Color fundus image; 45-degree field of view: 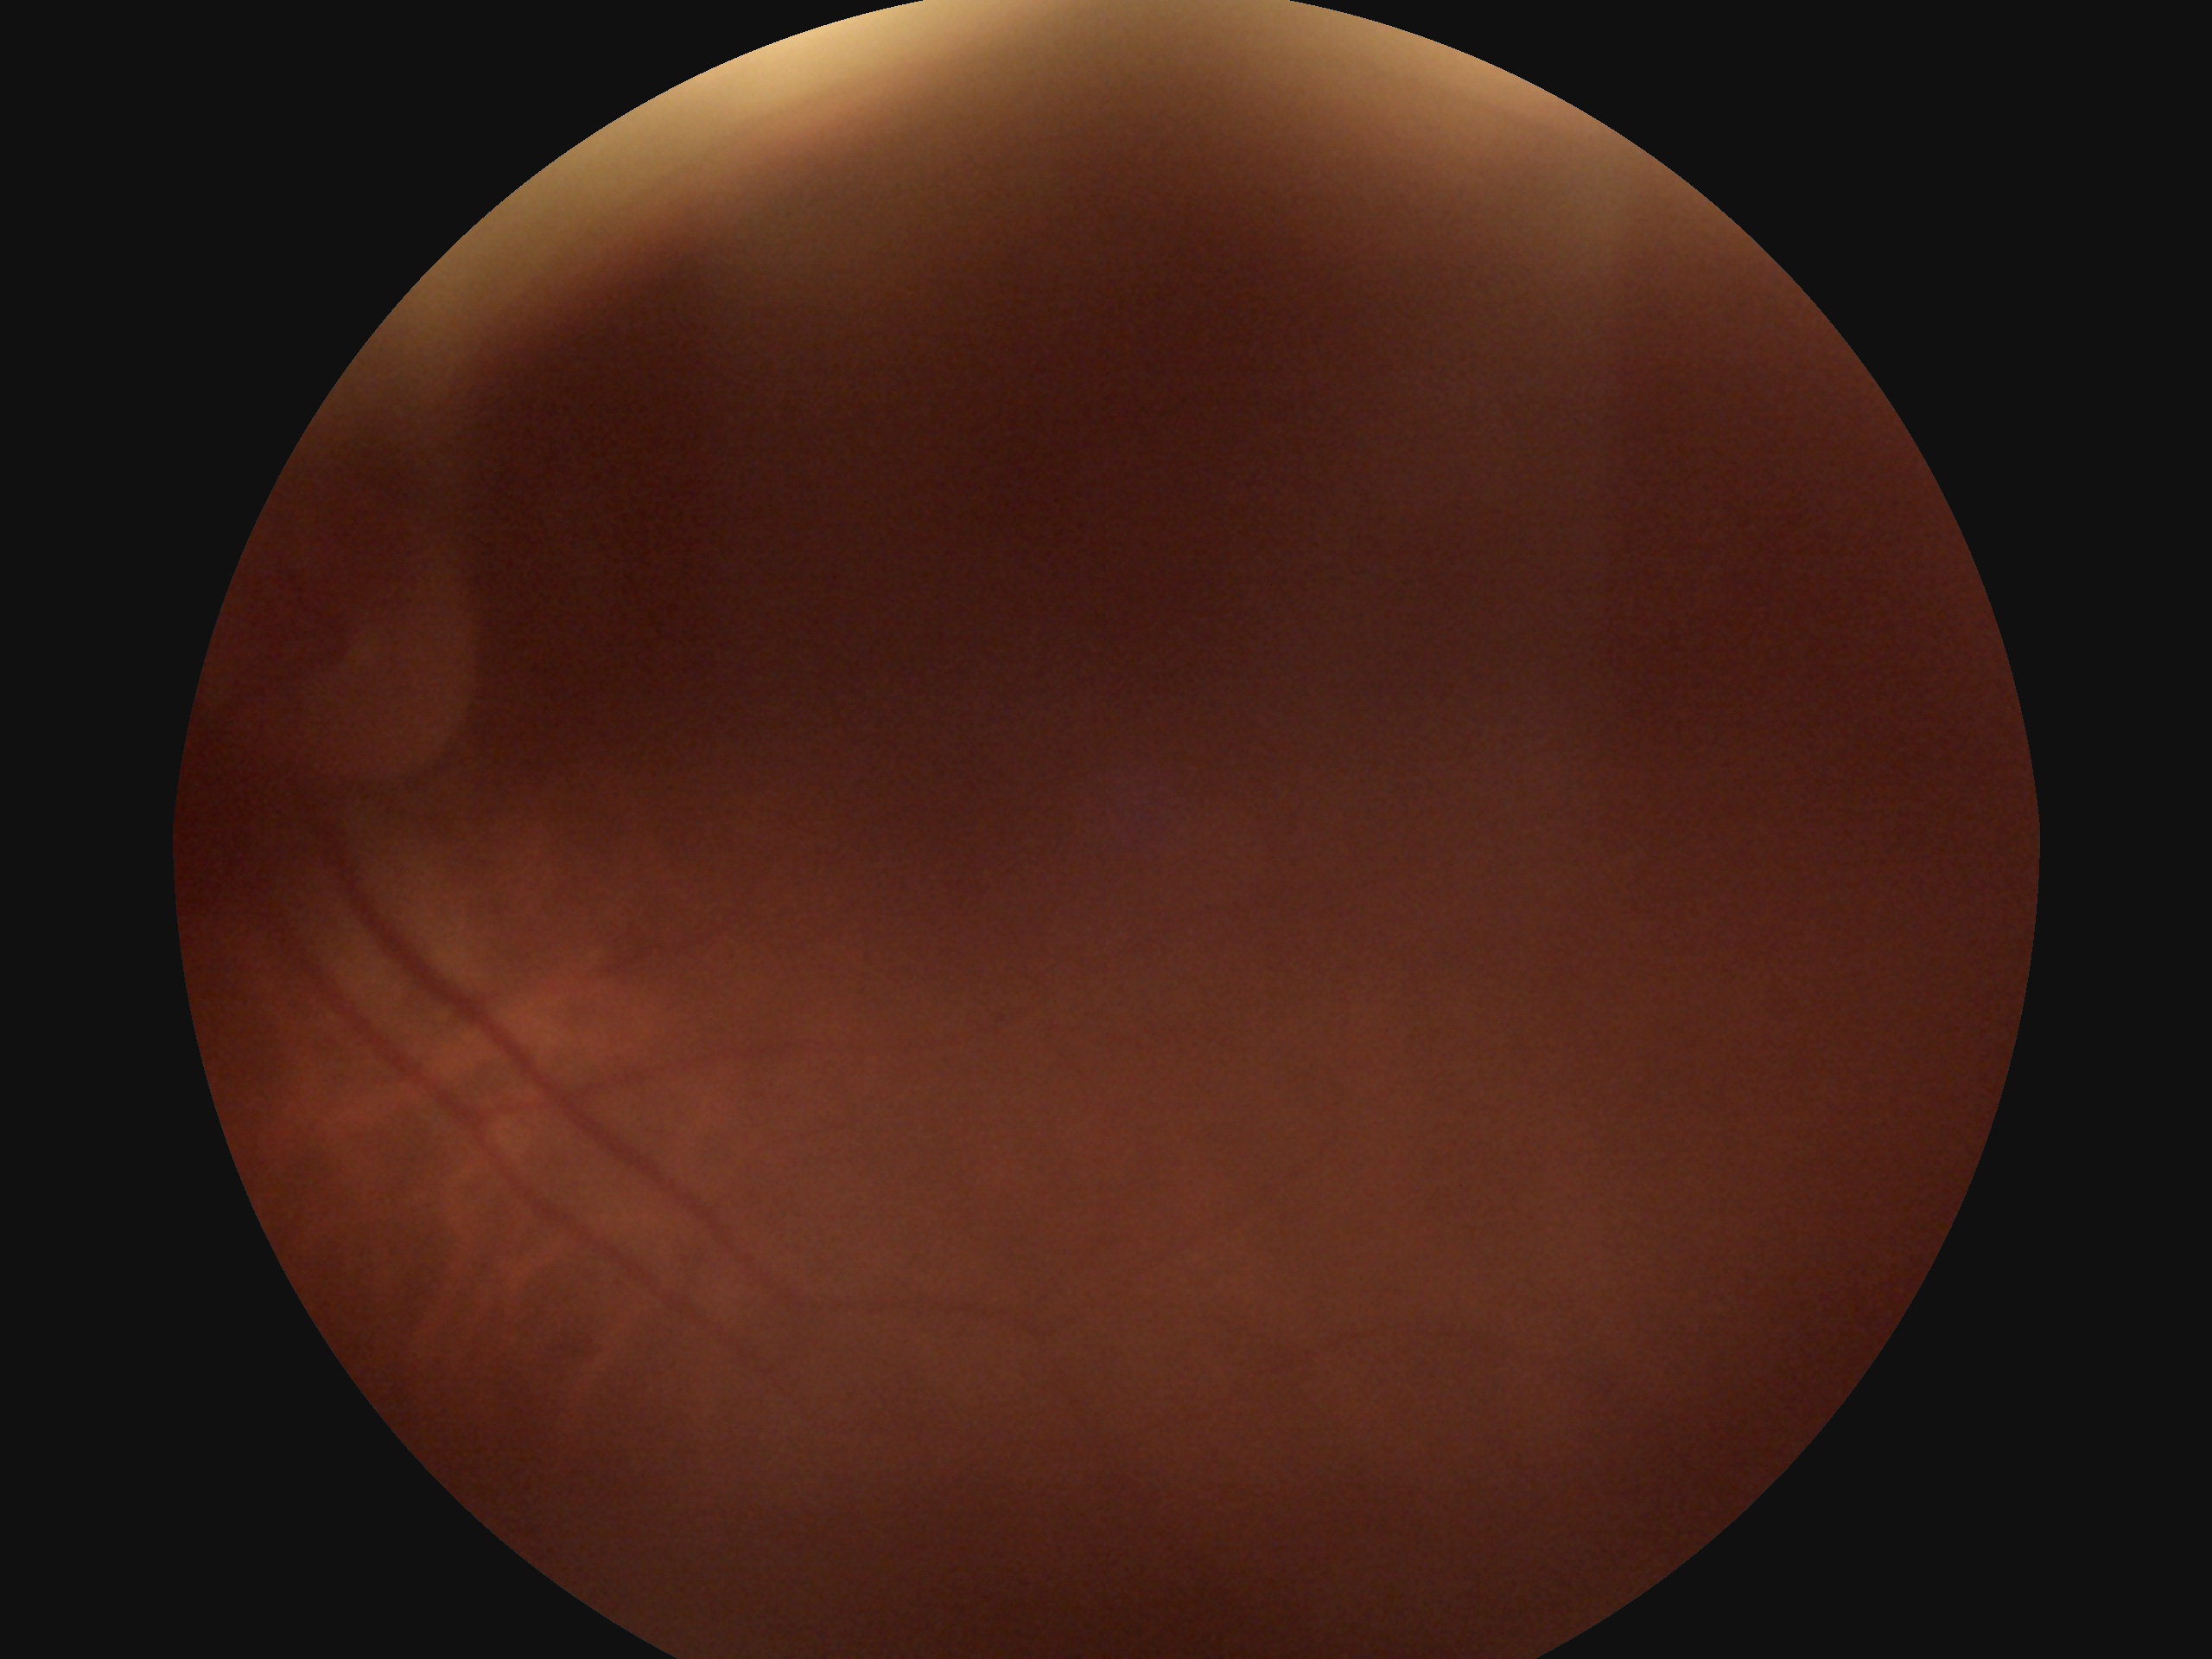
{
  "dr_grade": "ungradable due to poor image quality"
}